45° FOV. NIDEK AFC-230. CFP: 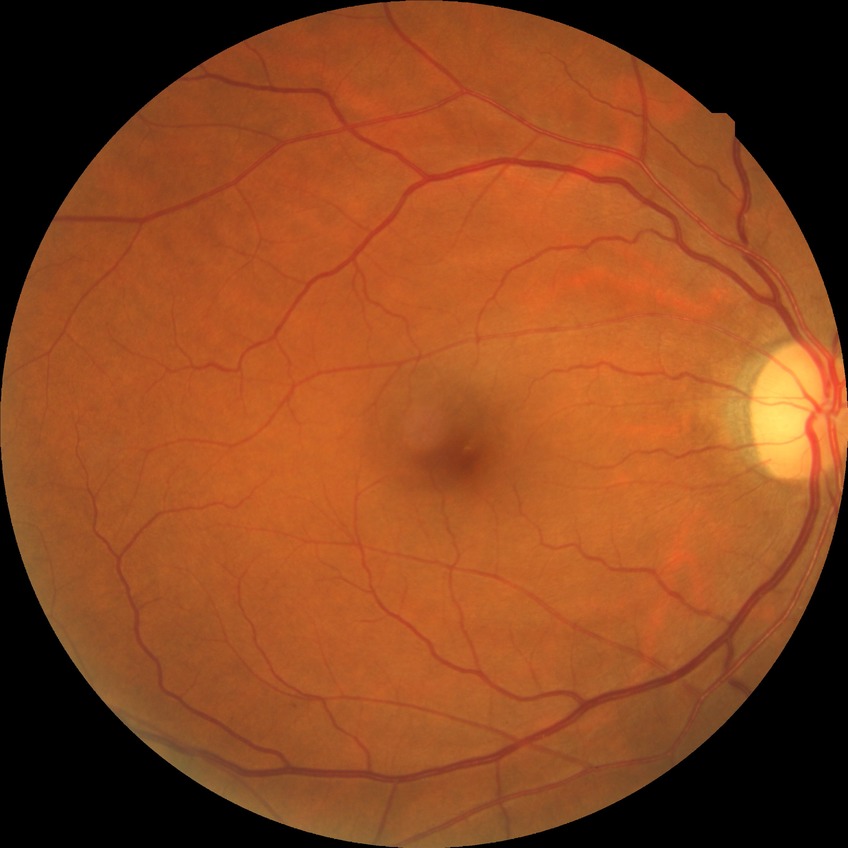
Davis grade: NDR.